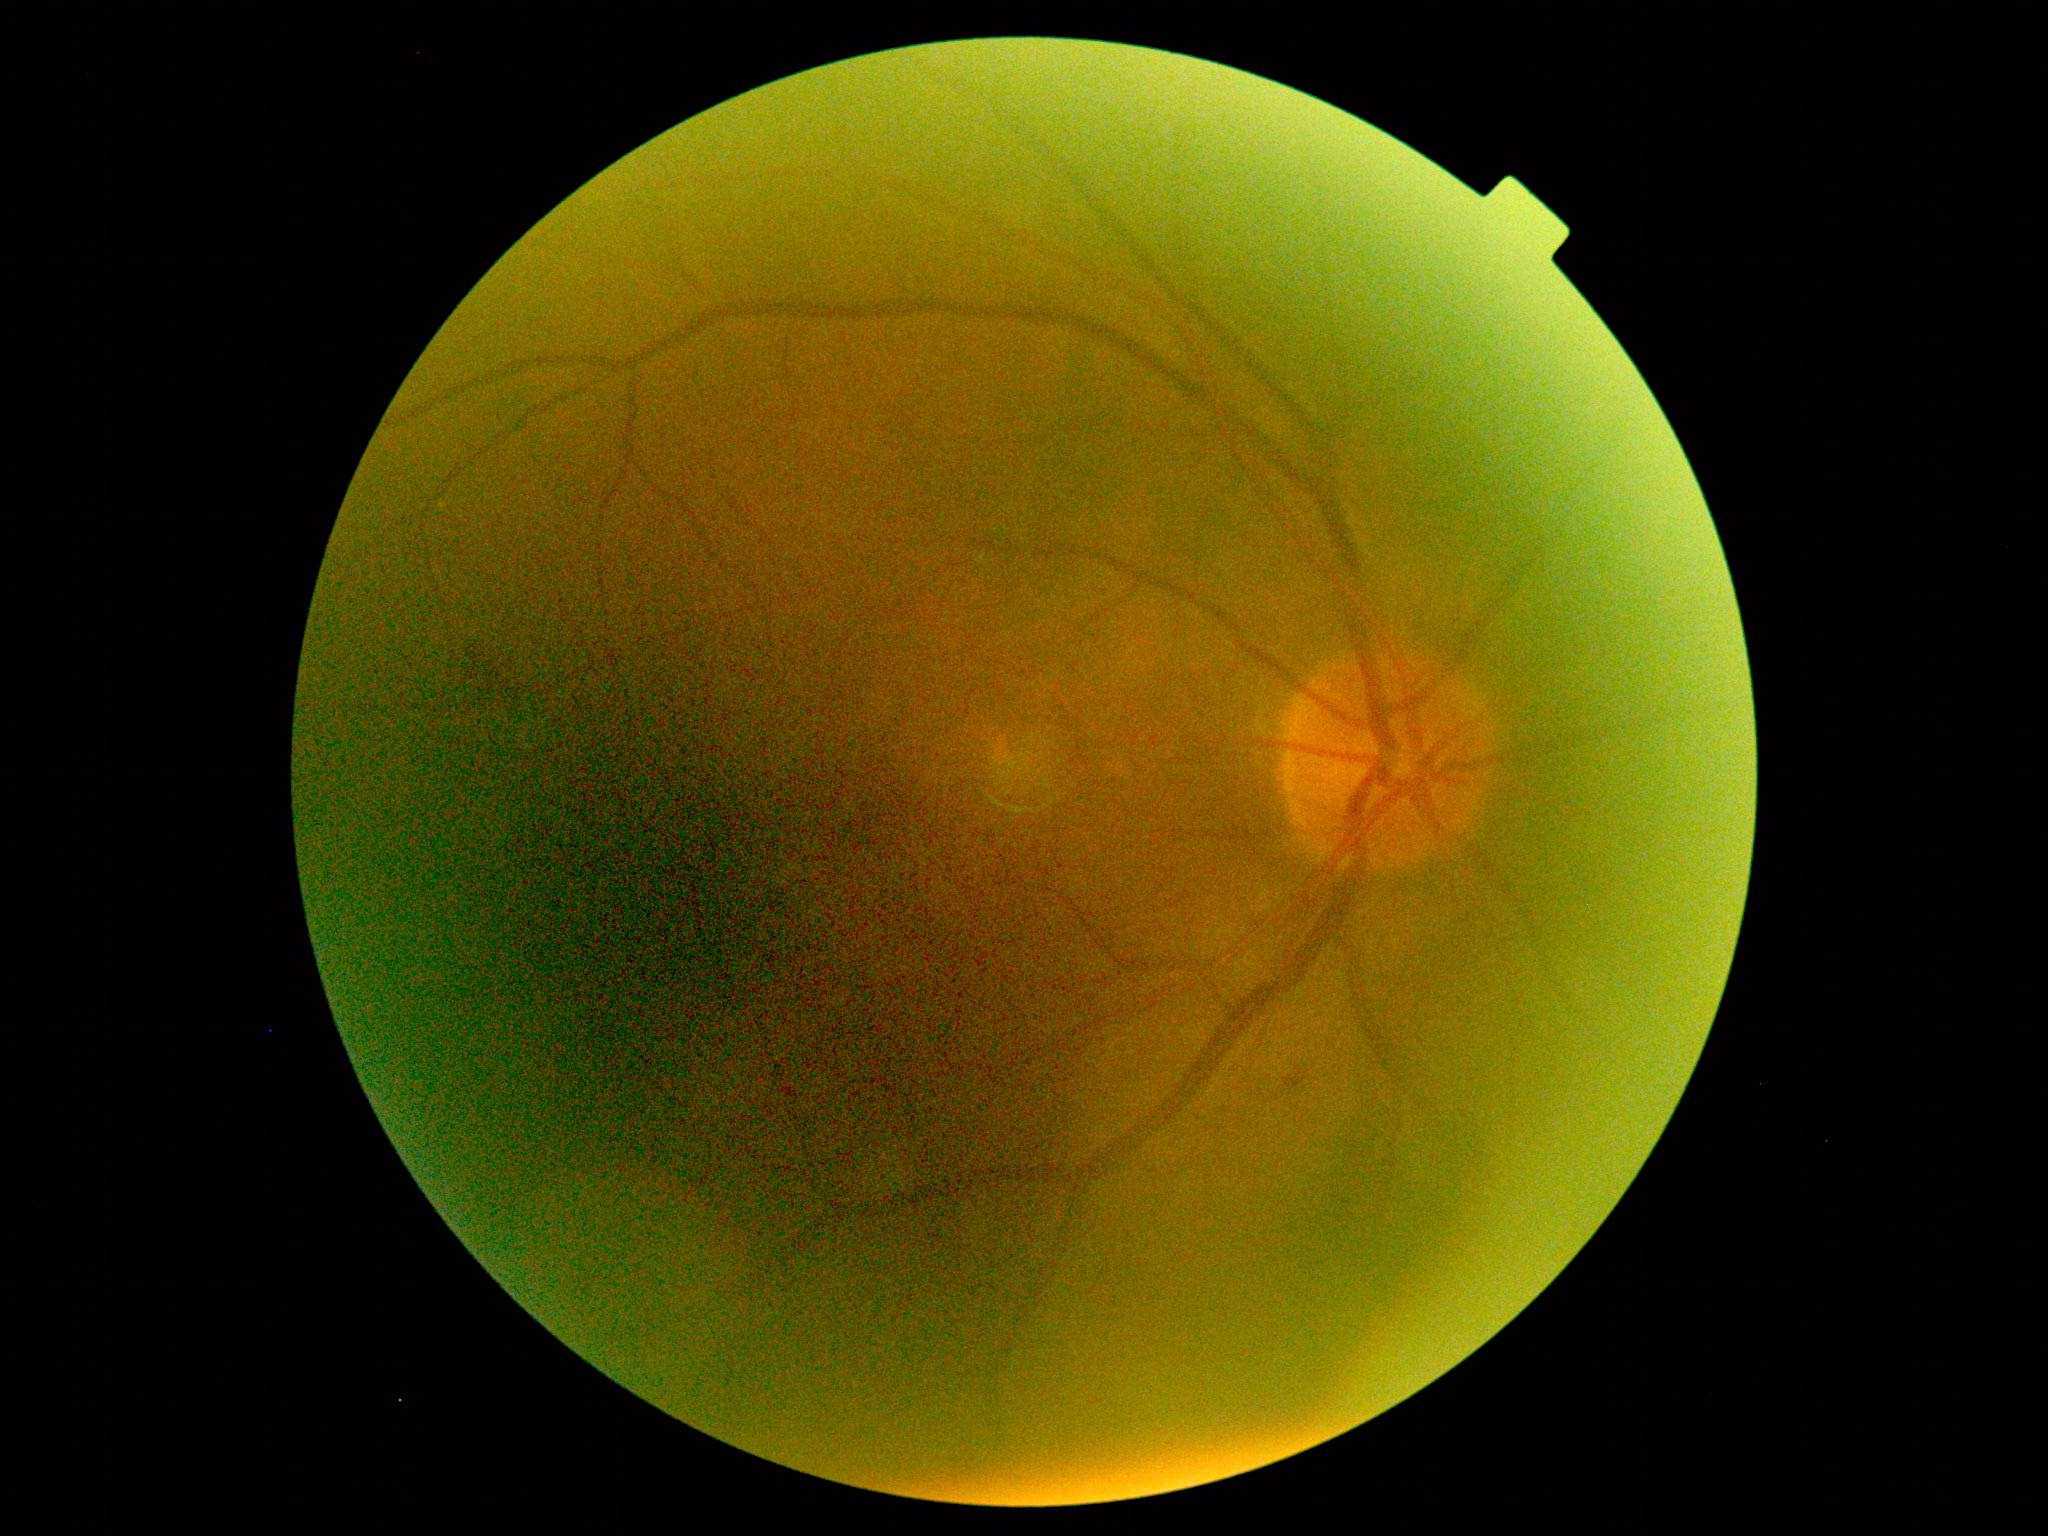
Annotations:
* DR — 2